Wide-field contact fundus photograph of an infant. 1240x1240px — 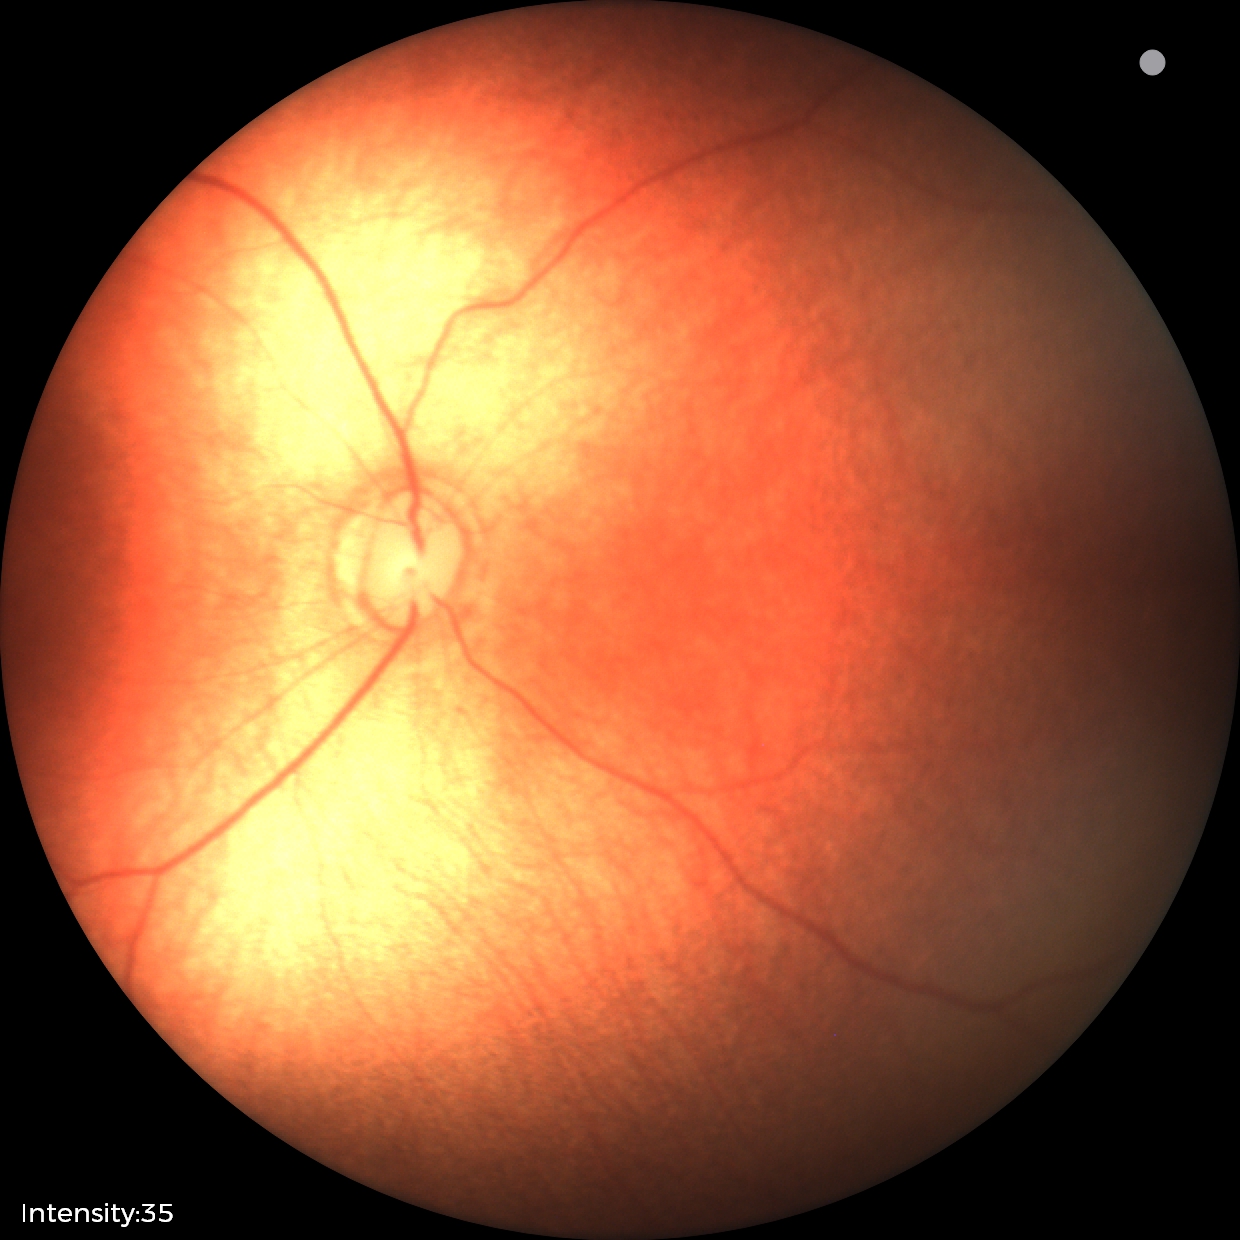
Physiological retinal appearance for postconceptual age.